Color fundus photograph · image size 512x512: 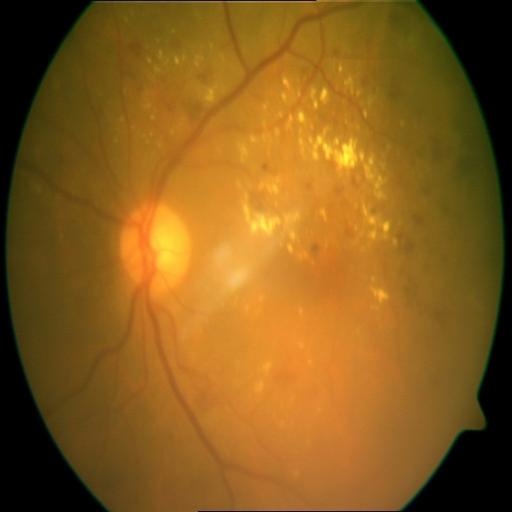 There is evidence of exudation.